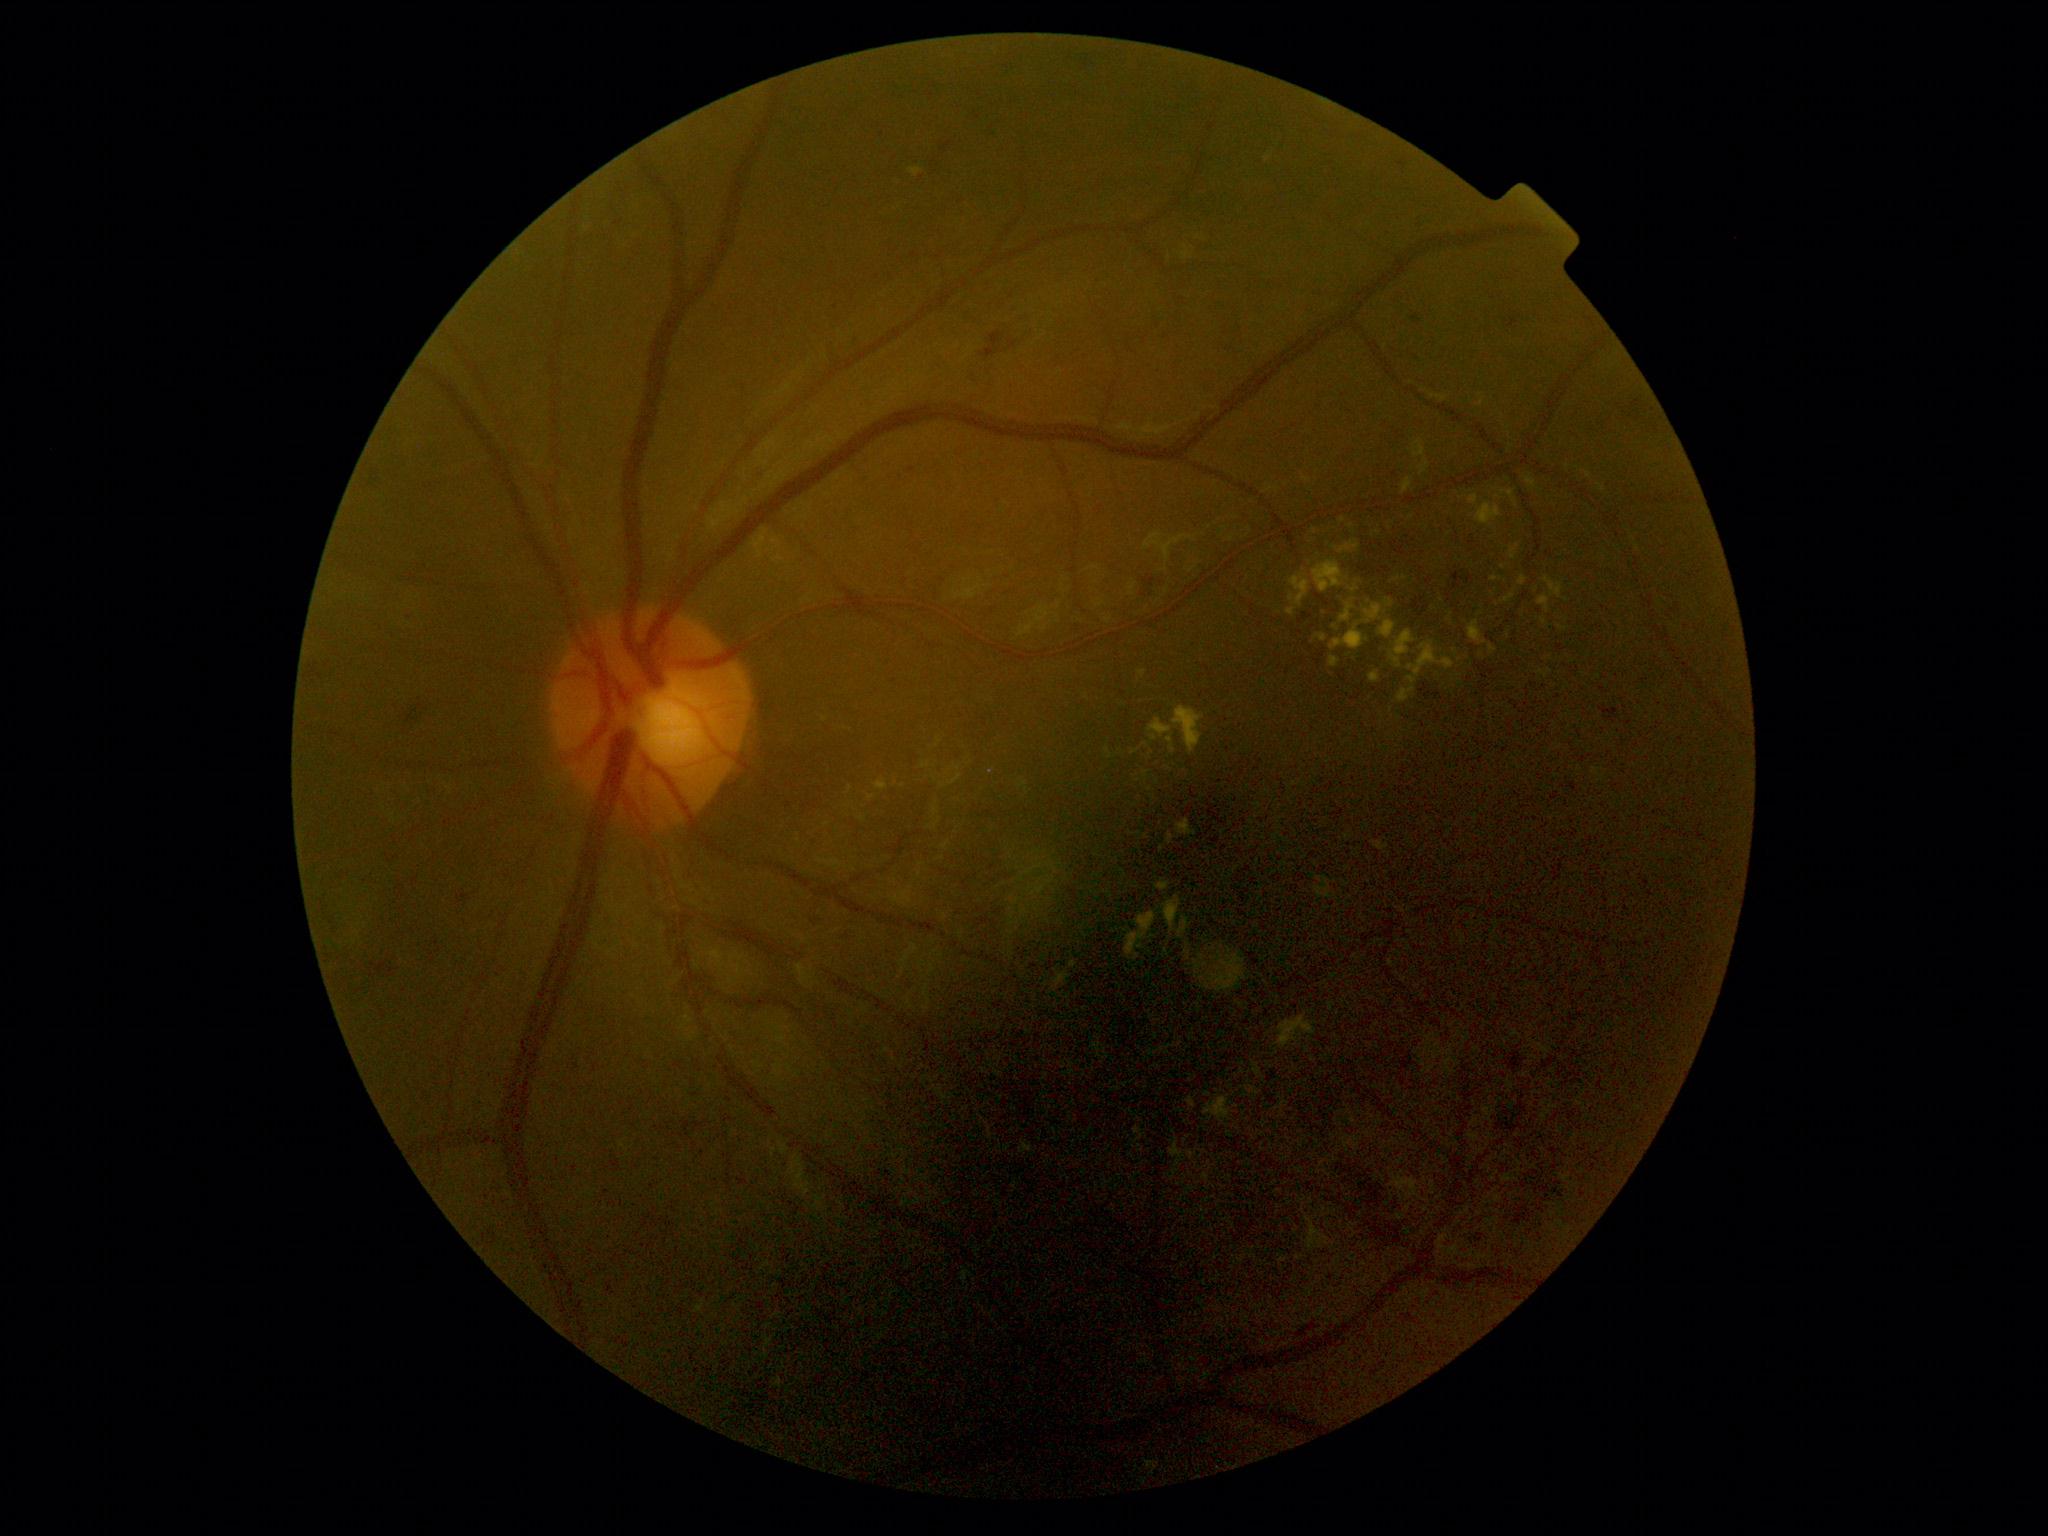 Retinopathy grade: 2/4.
Hard exudates include those at 1204 1097 1233 1128 | 1287 609 1296 616 | 1537 669 1552 678 | 1372 842 1389 852 | 1468 621 1488 646 | 1365 605 1382 625 | 1277 1014 1318 1050 | 1253 1063 1266 1083 | 775 1379 783 1389 | 1183 247 1190 261.
Hard exudates (small, approximate centers) near (x=1236, y=1107) | (x=1442, y=558) | (x=1550, y=658) | (x=1336, y=628) | (x=1455, y=652) | (x=1230, y=1135) | (x=1390, y=528).